45-degree field of view, retinal fundus photograph: 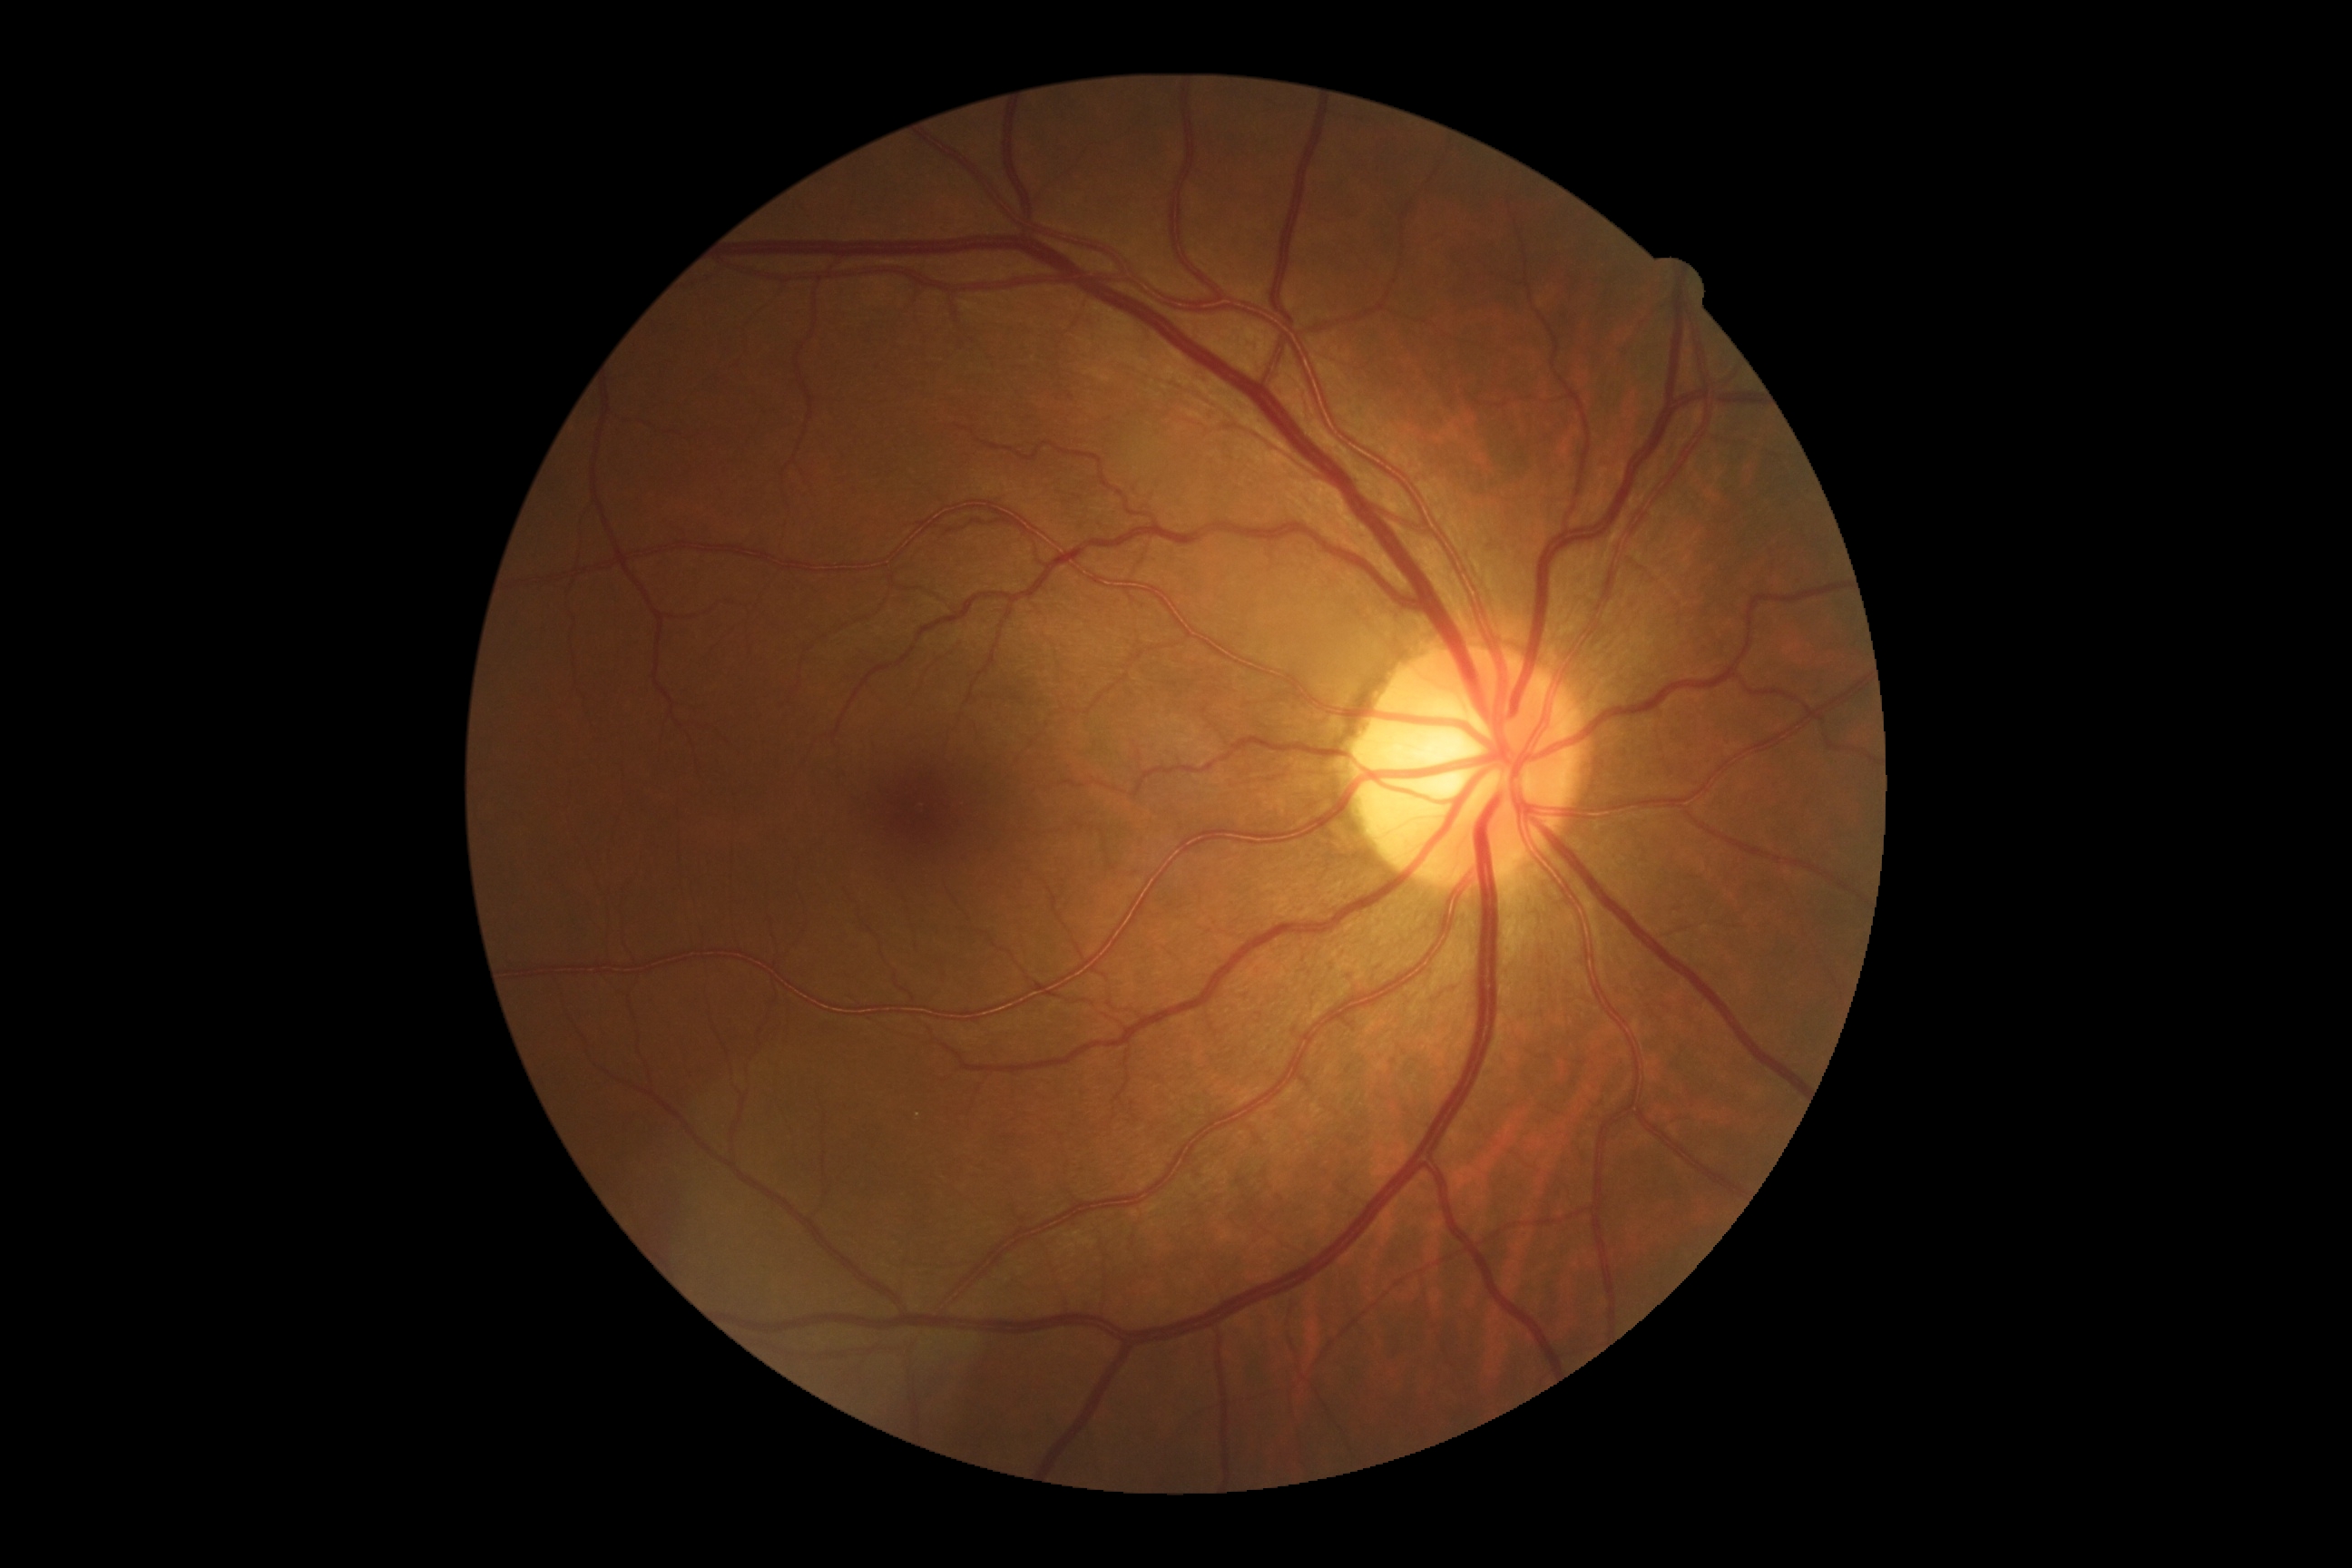

Diabetic retinopathy (DR) is grade 0 (no apparent retinopathy).